1440 x 1080 pixels. Wide-field contact fundus photograph of an infant — 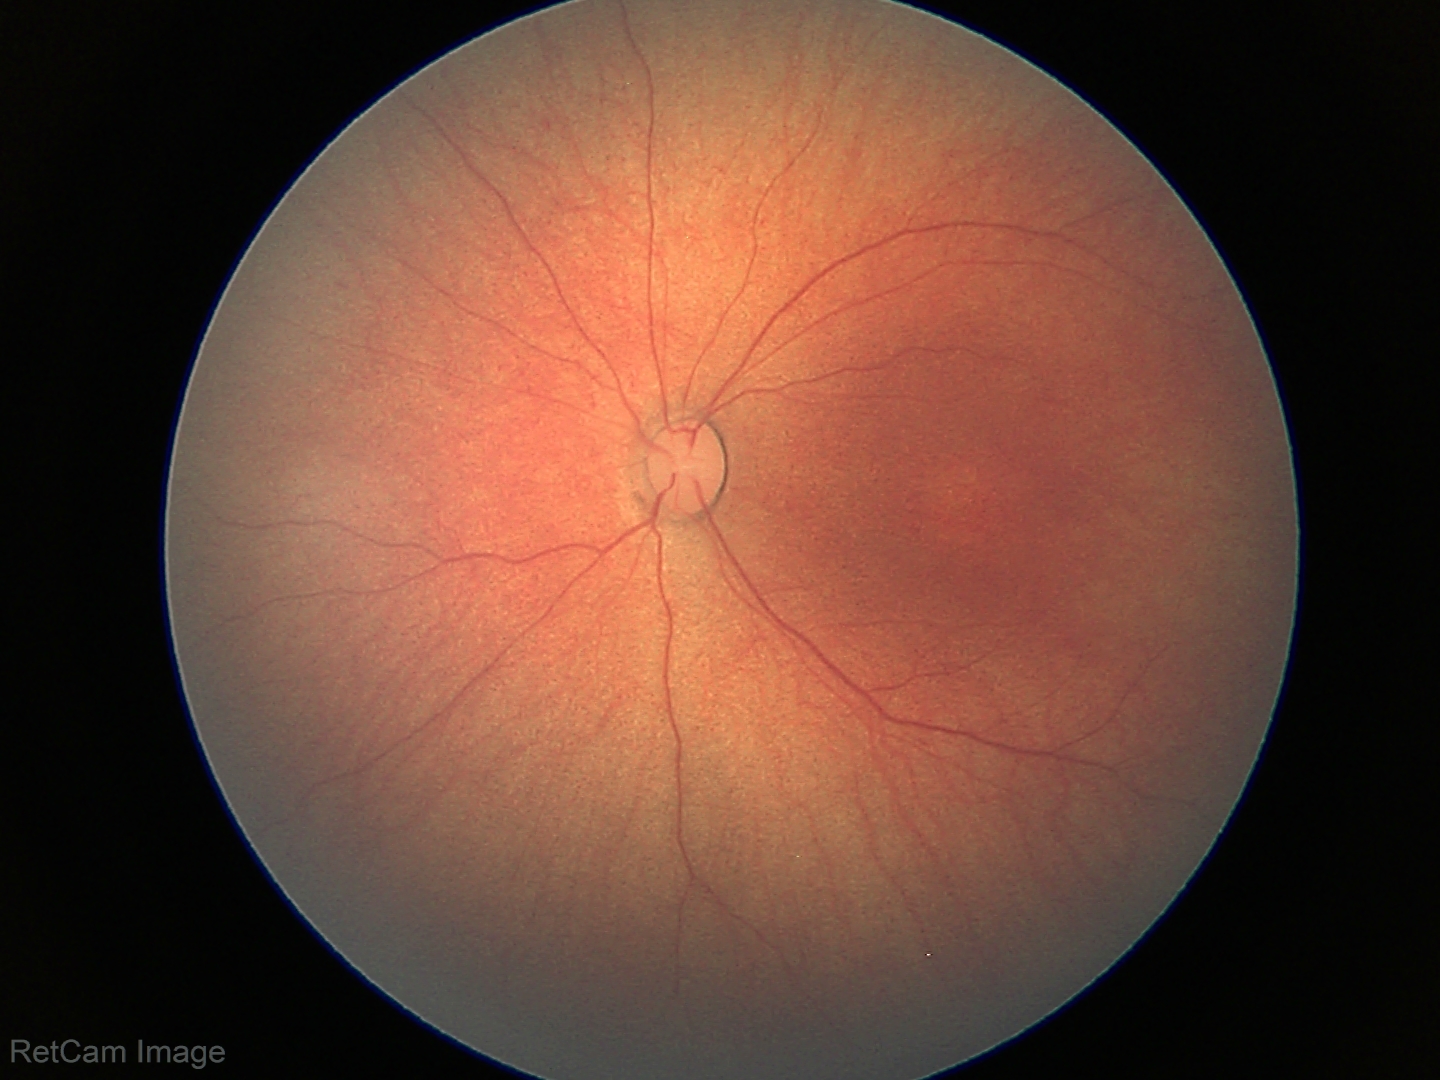

Screening examination diagnosed as physiological.